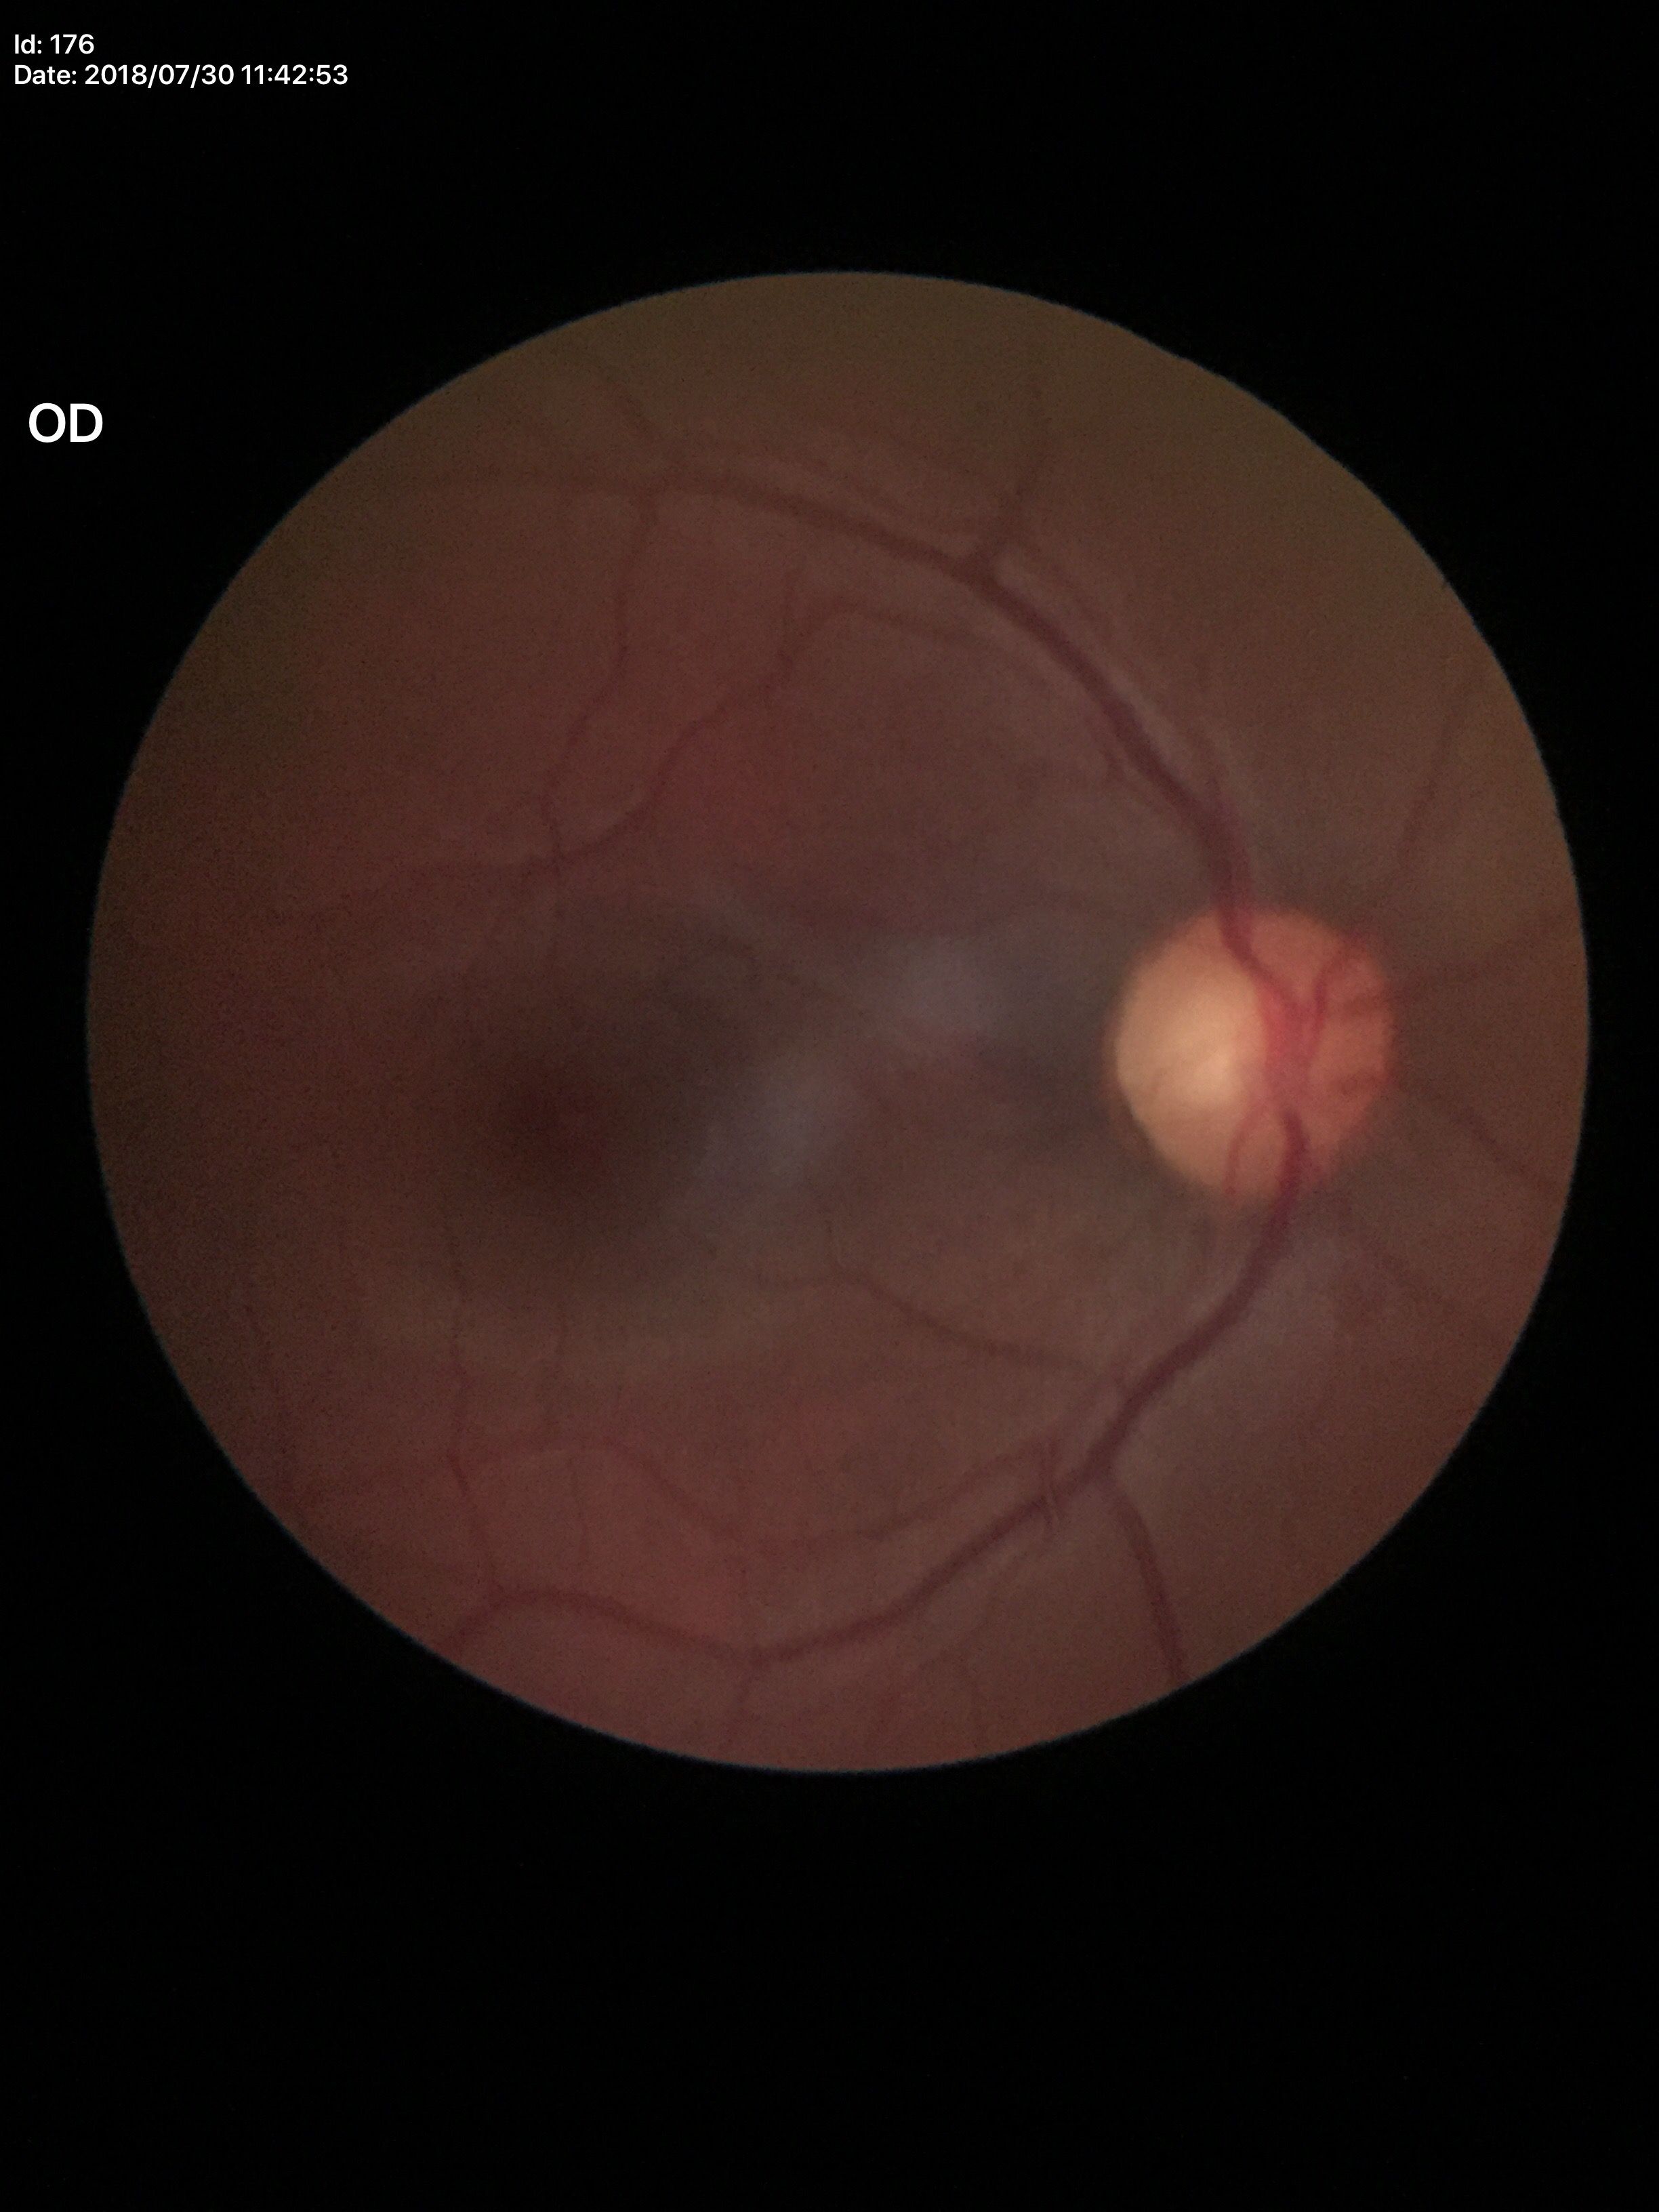

{
  "glaucoma_decision": "negative (1 of 5 graders flagged glaucoma suspect)",
  "vcdr": "0.57"
}